Infant wide-field retinal image: 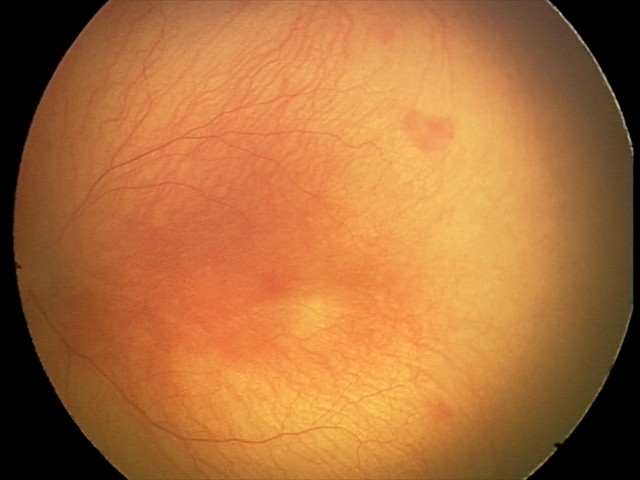
Q: What is the diagnosis from this examination?
A: aggressive retinopathy of prematurity
Q: Plus disease status?
A: plus disease